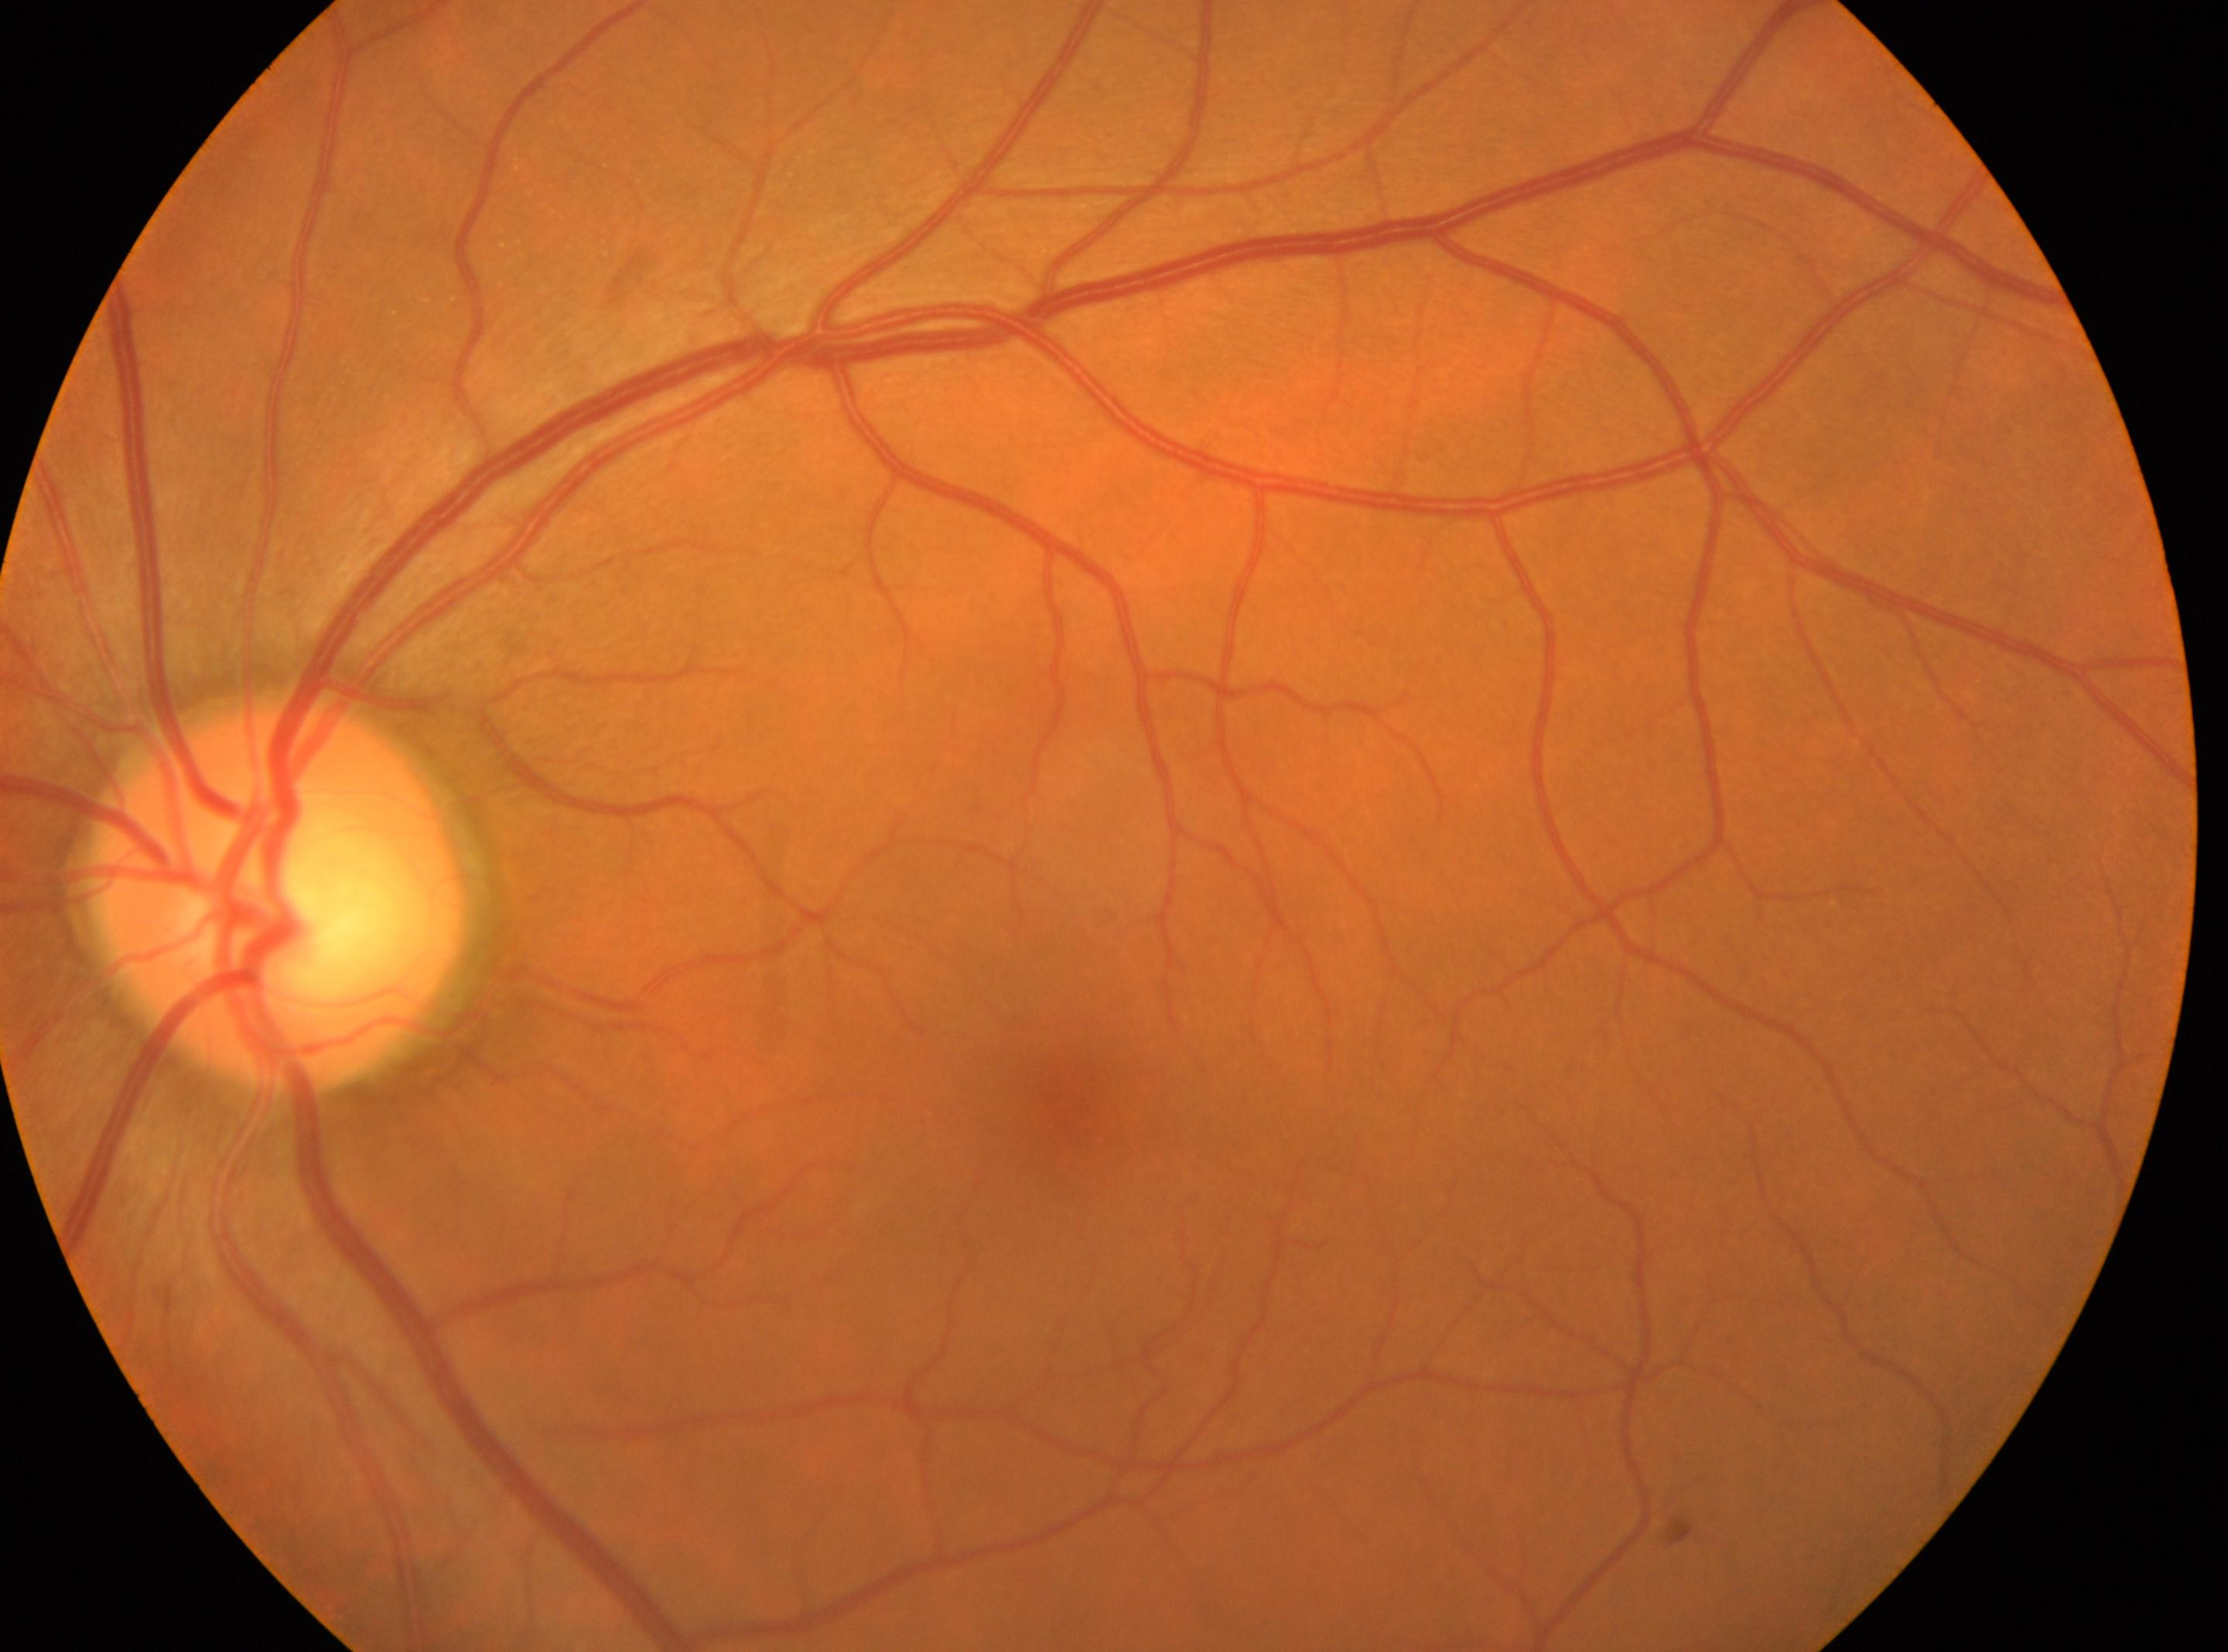

Imaged eye: left.
The fovea center is at [1086, 1123].
No signs of diabetic retinopathy.
Retinopathy is 0/4 — no visible signs of diabetic retinopathy.
The optic disc is at [272, 897].